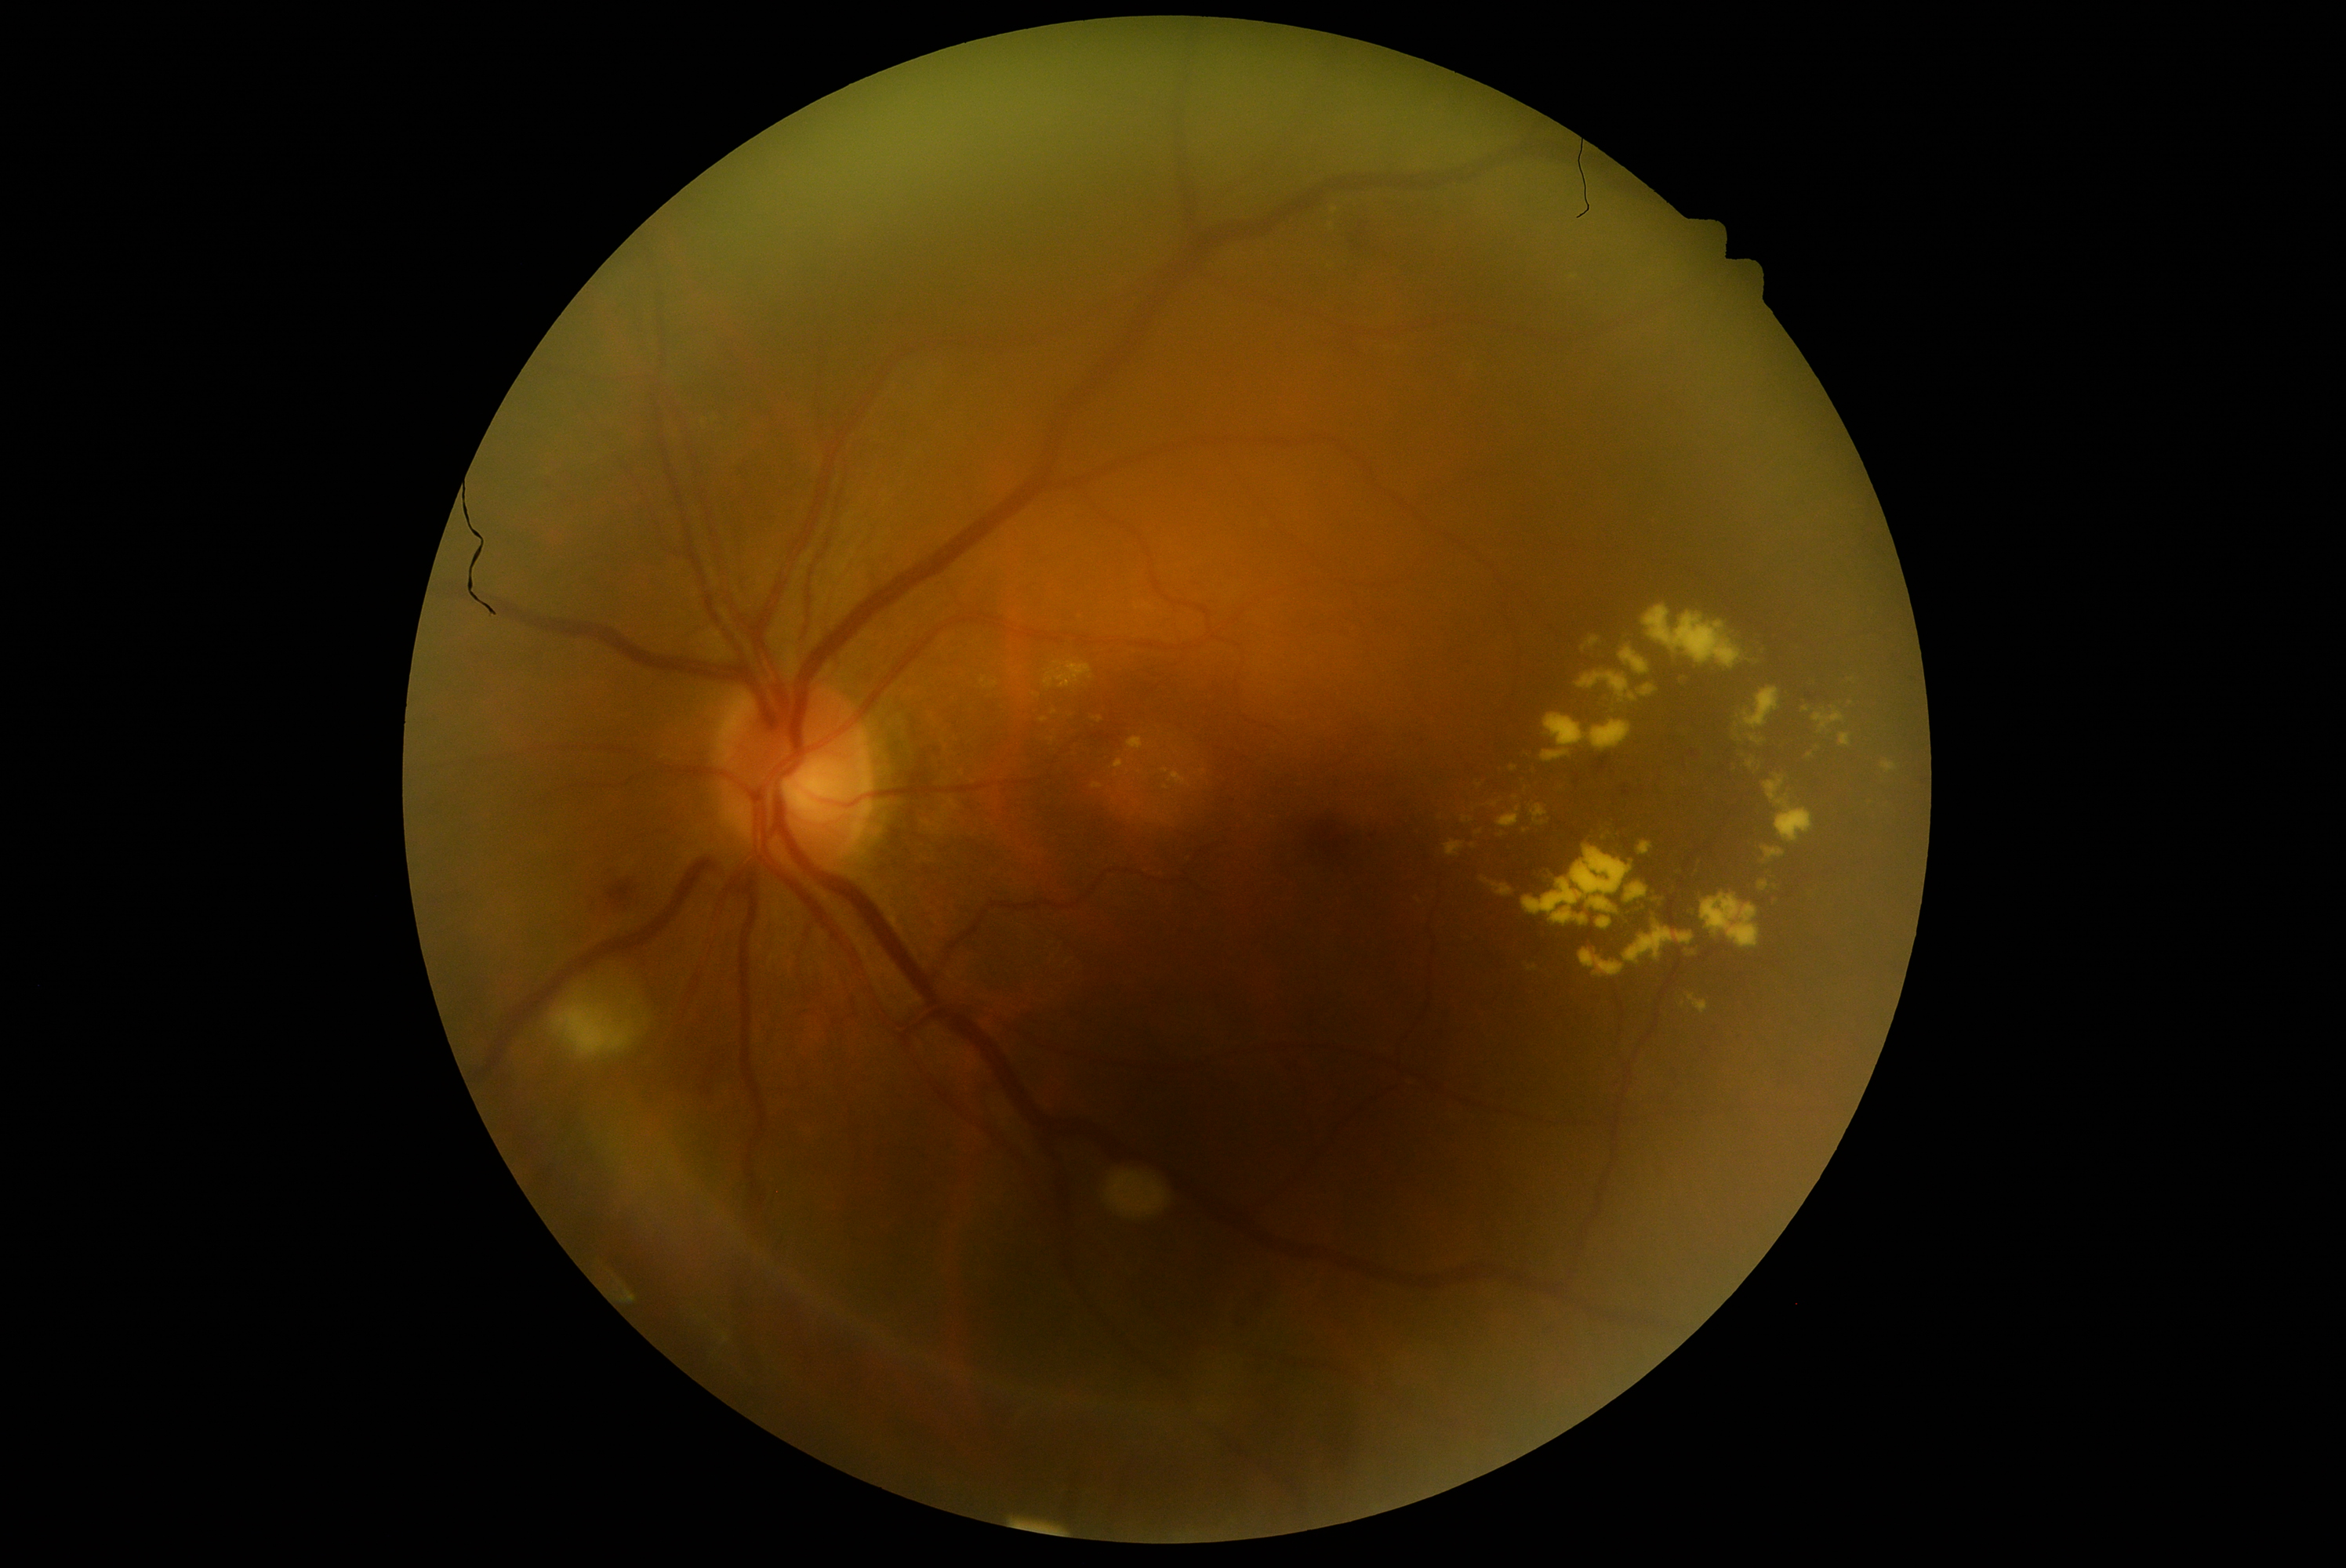 Diabetic retinopathy (DR) is grade 2 — more than just microaneurysms but less than severe NPDR.